Color fundus photograph — 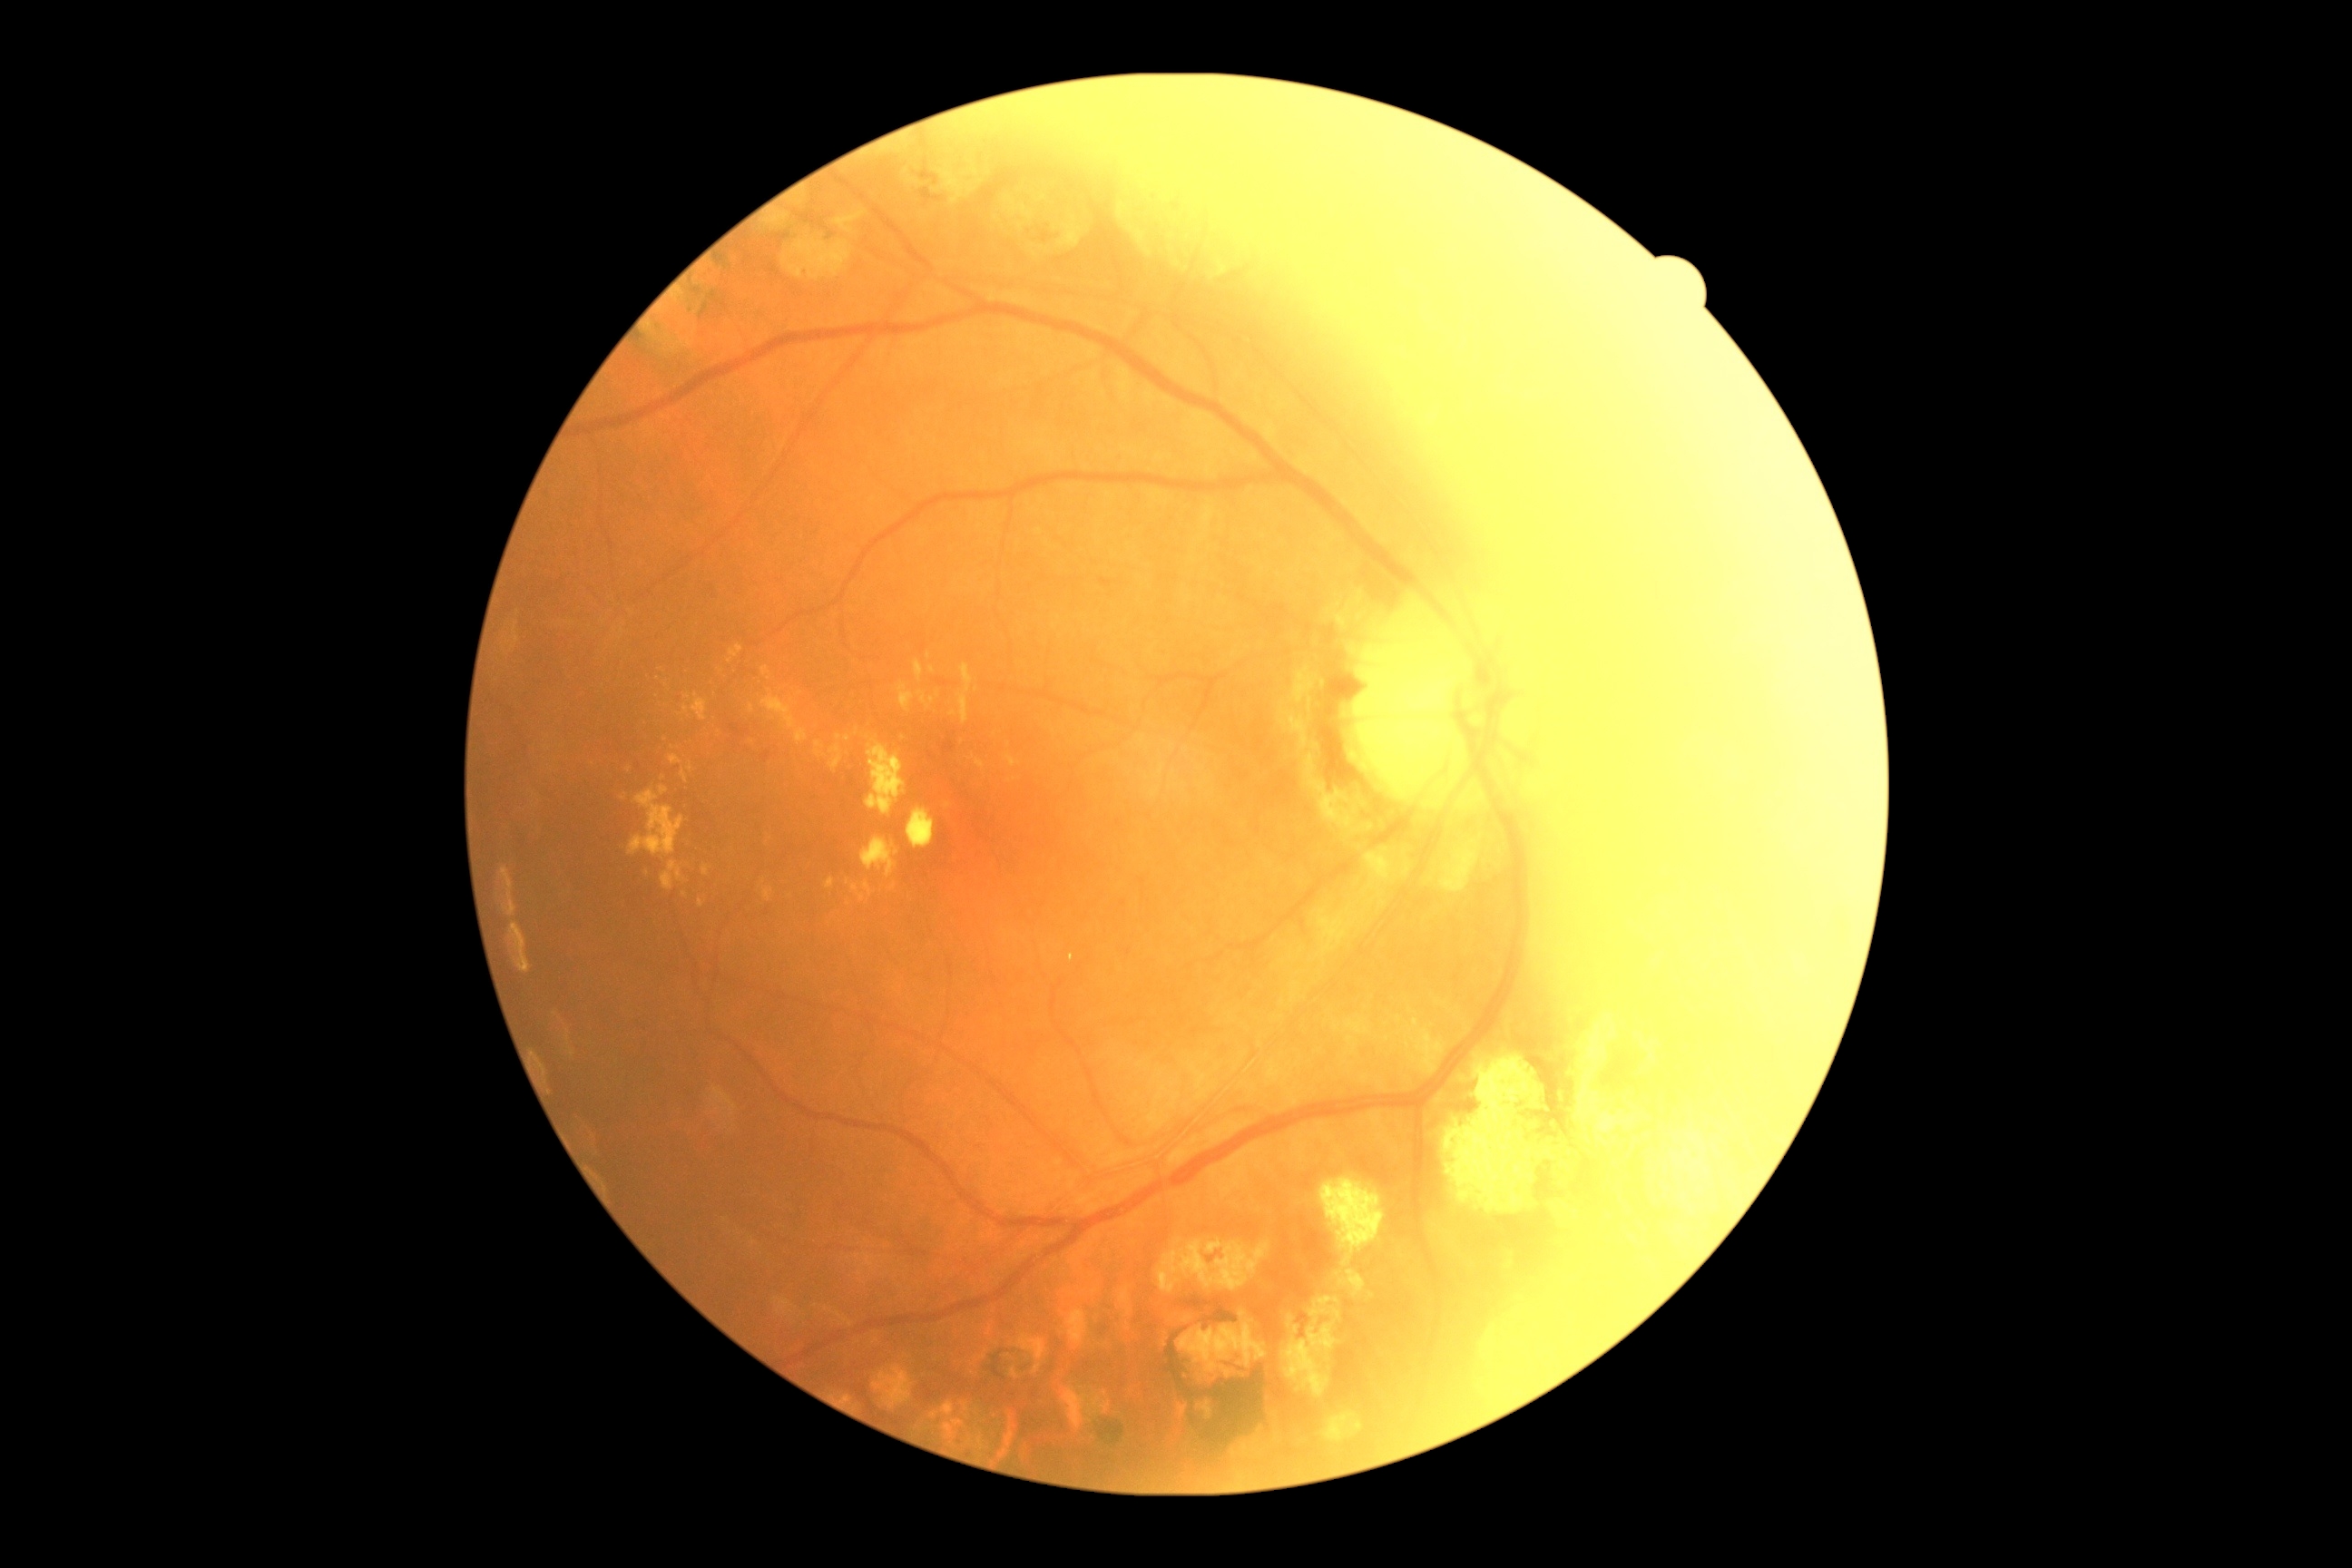

DR stage is grade 2. The retinopathy is classified as non-proliferative diabetic retinopathy.